Color fundus photograph — 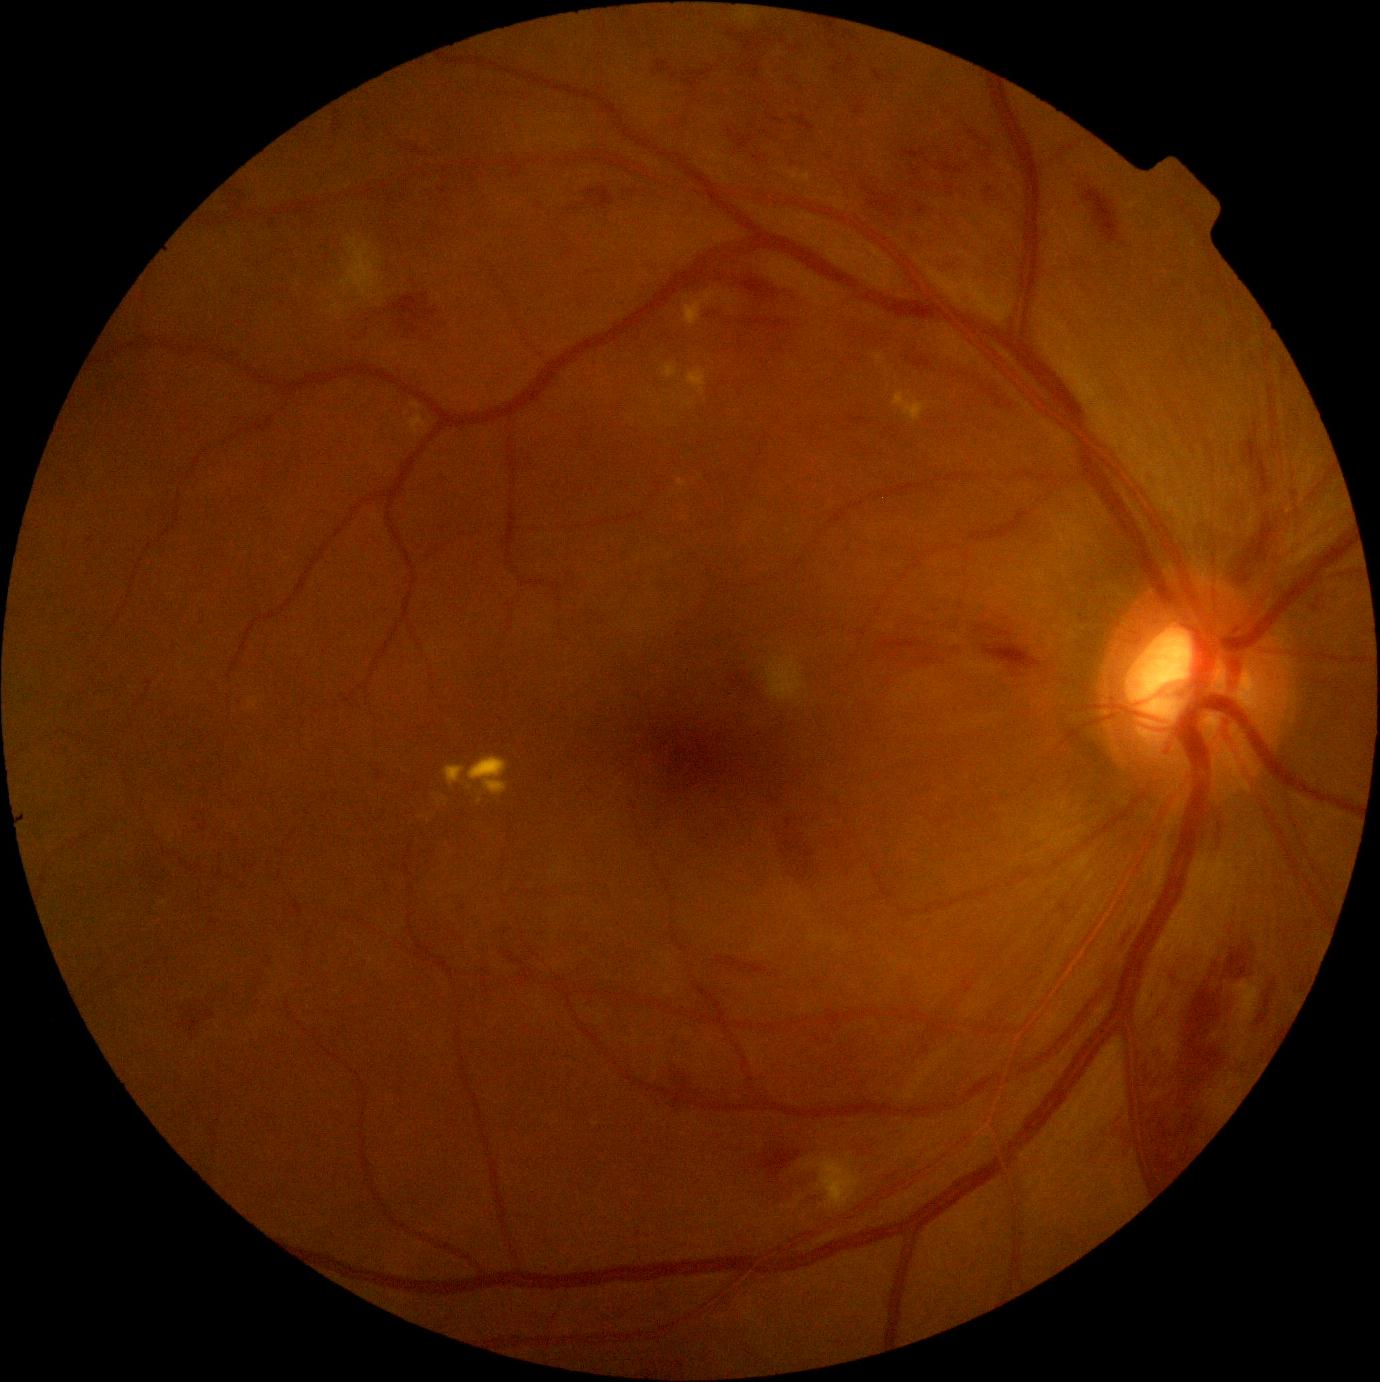

Diabetic retinopathy (DR) is moderate non-proliferative diabetic retinopathy (grade 2).